Mydriatic (tropicamide and phenylephrine).
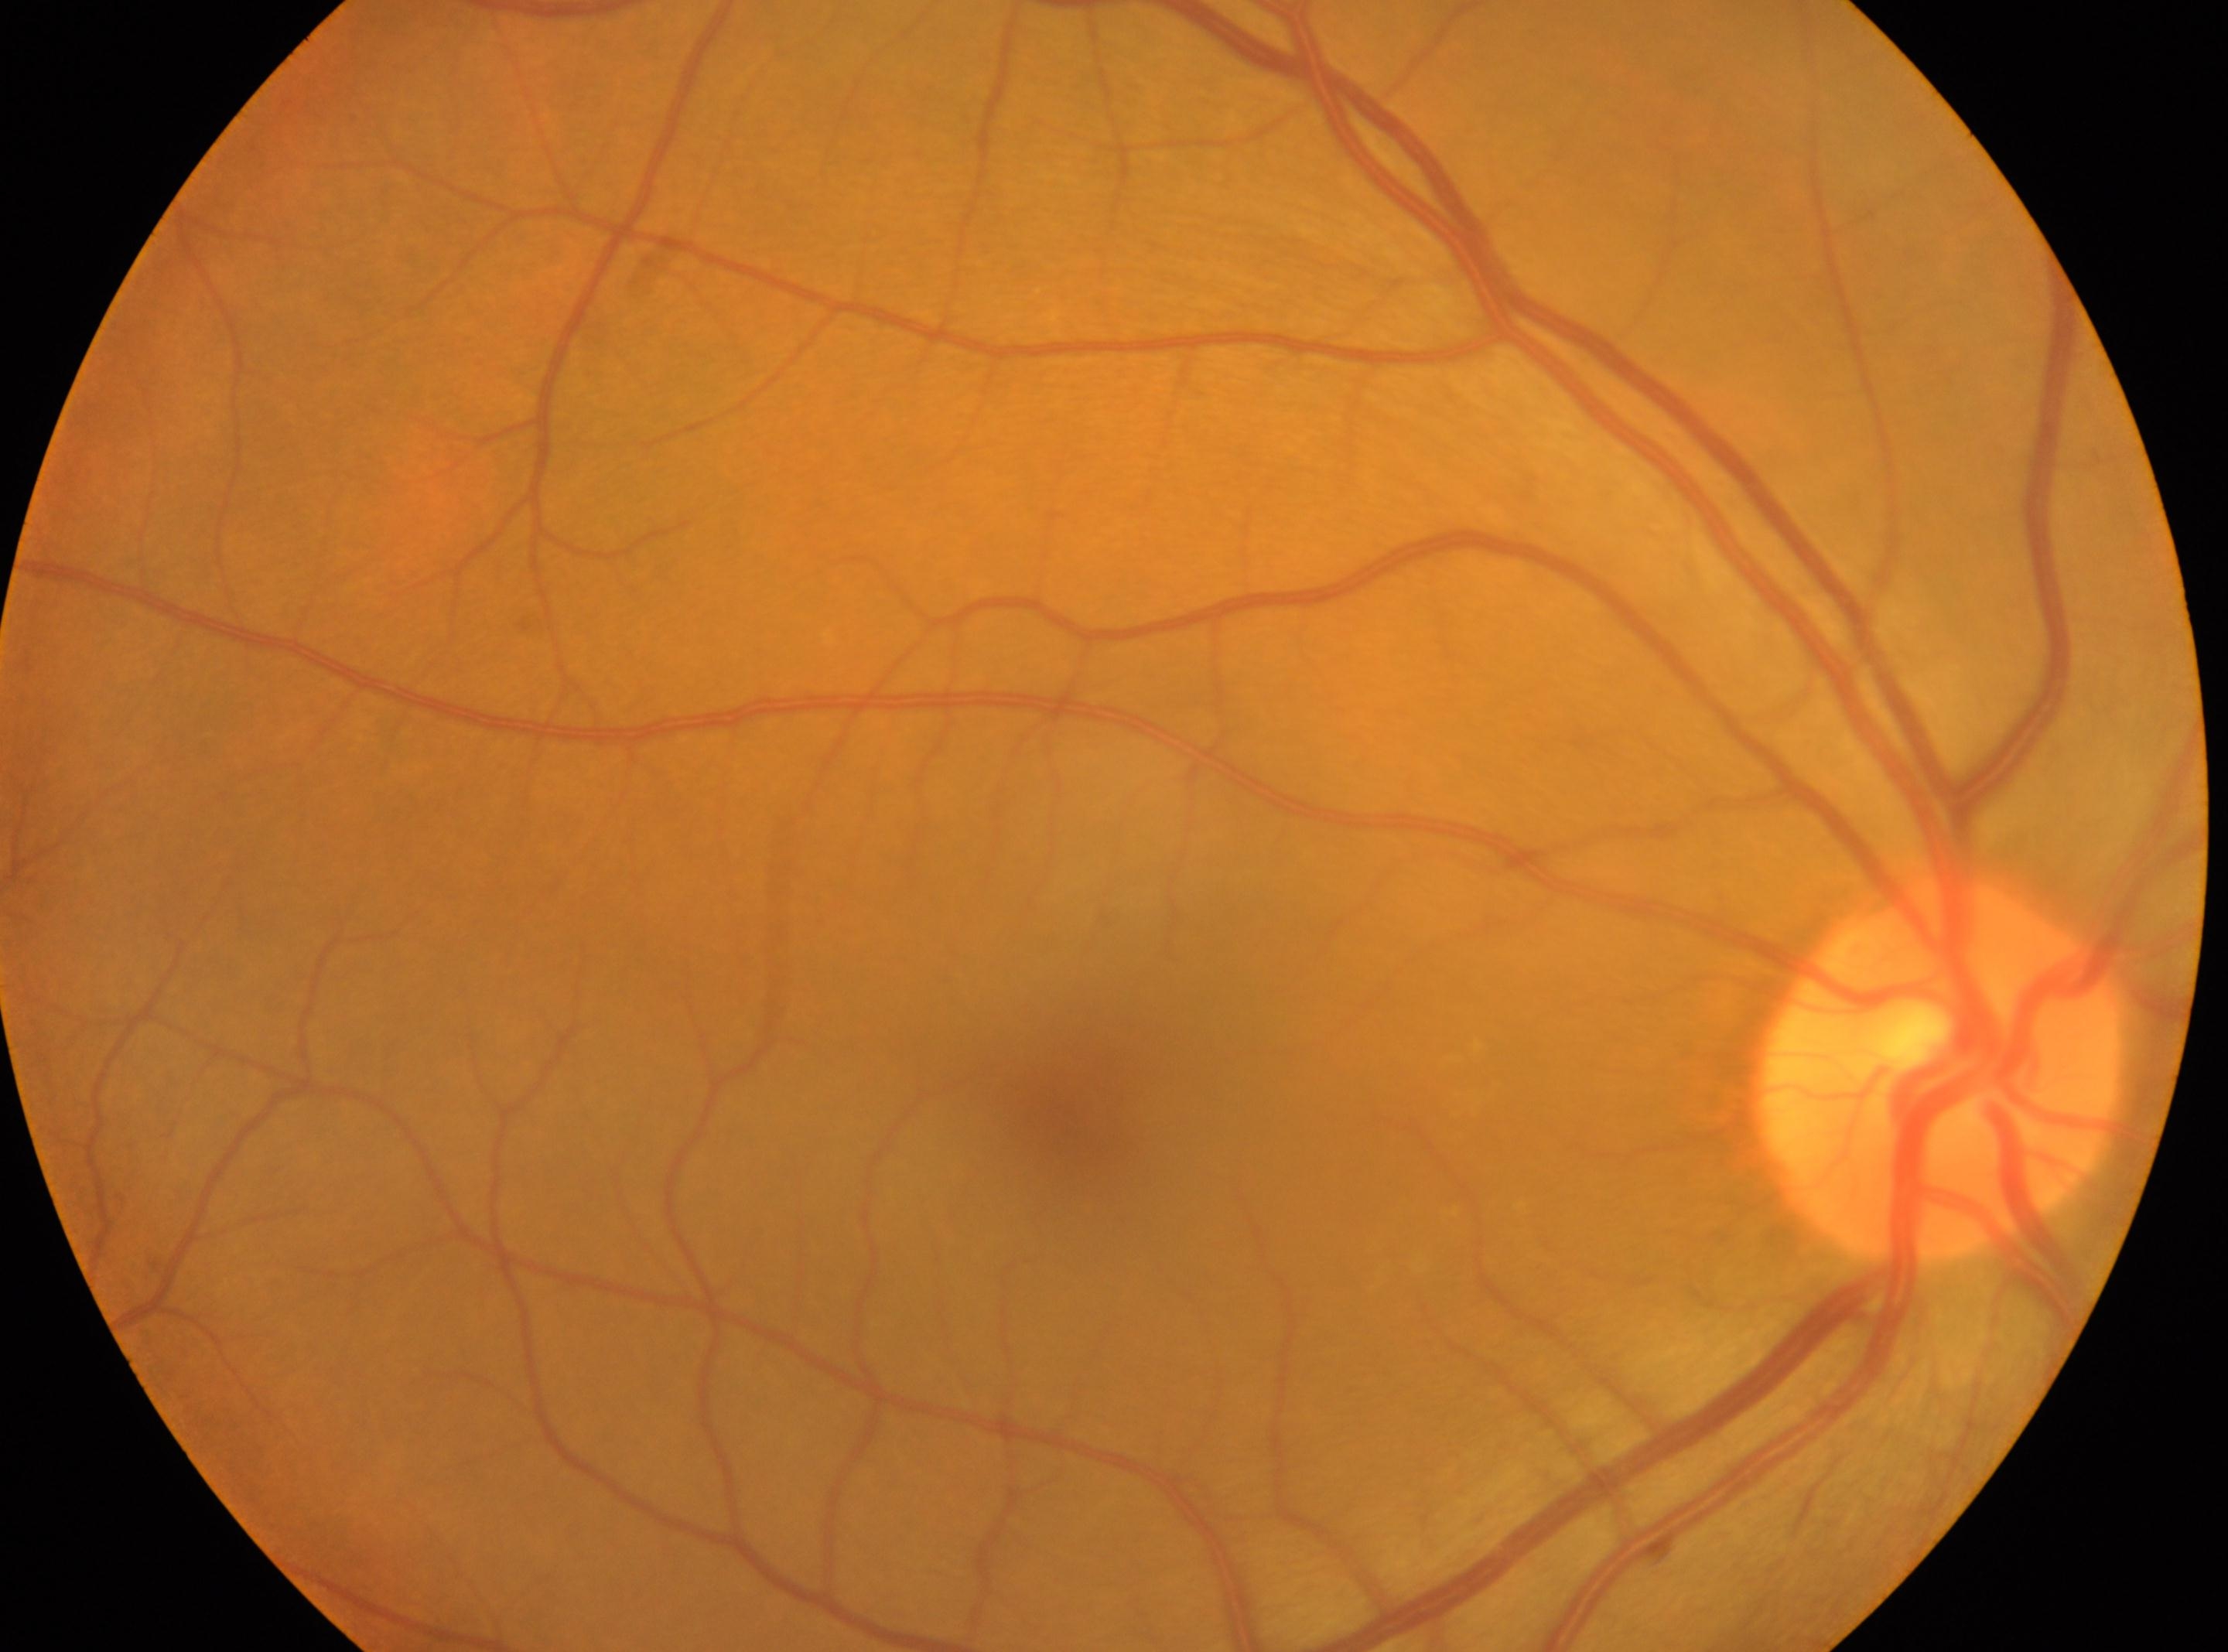 Diabetic retinopathy is grade 0 (no apparent retinopathy).
Optic disc located at x=1943, y=1070.
Eye: right eye.
Fovea: x=1066, y=1114.